1240x1240px · pediatric retinal photograph (wide-field) — 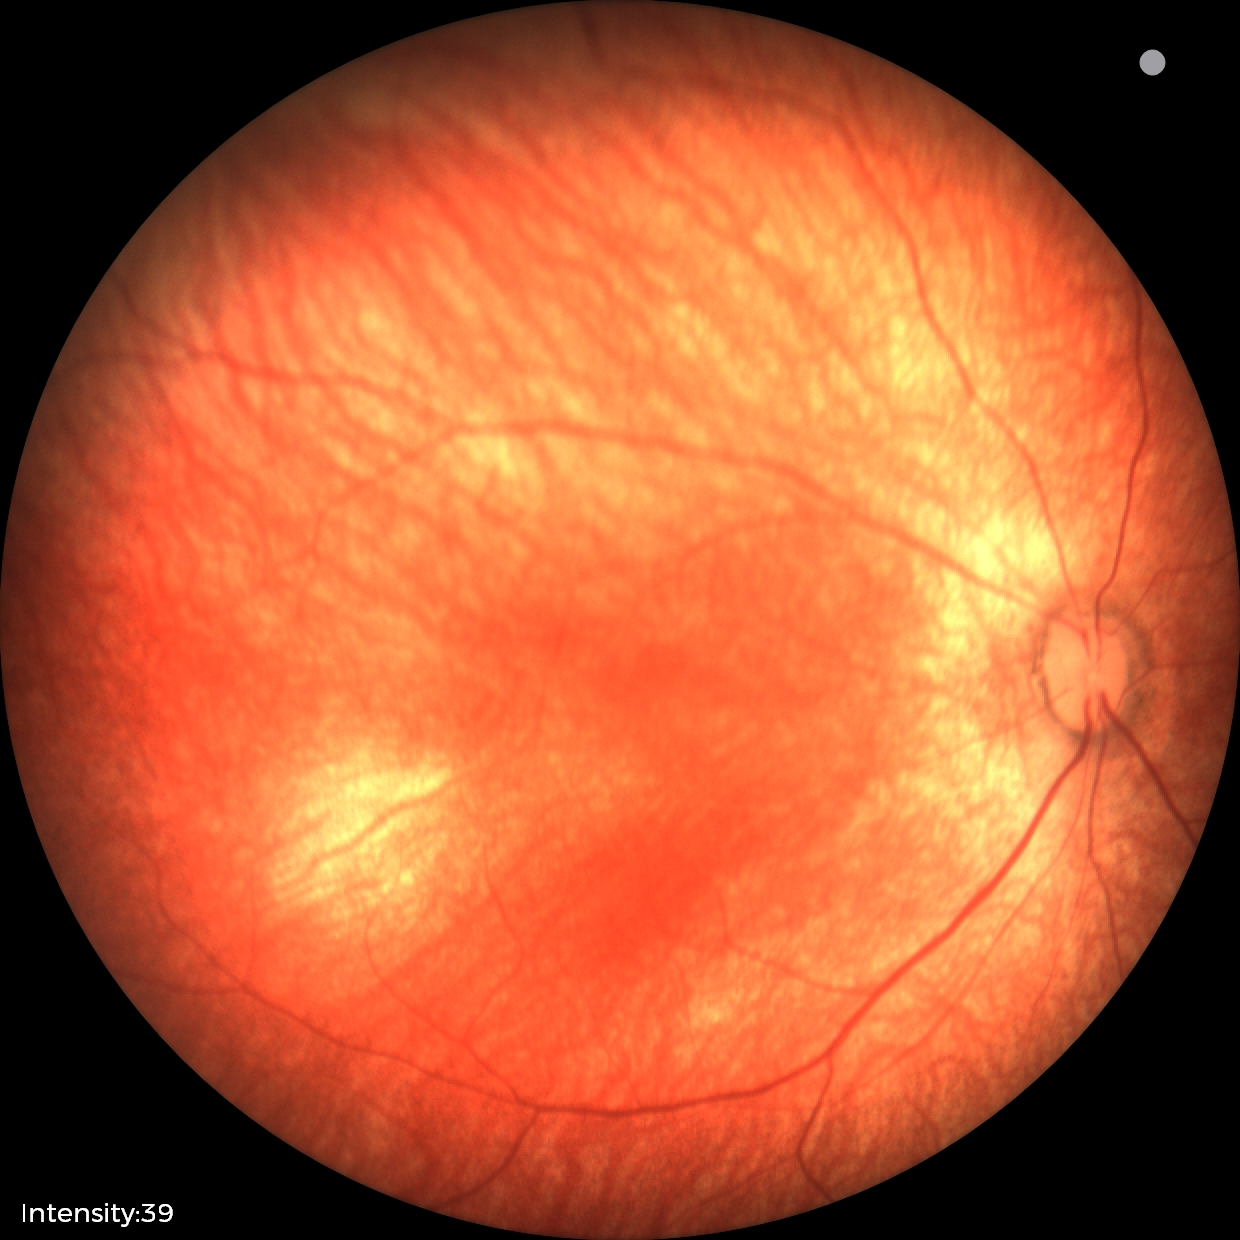 No retinal pathology identified on screening.